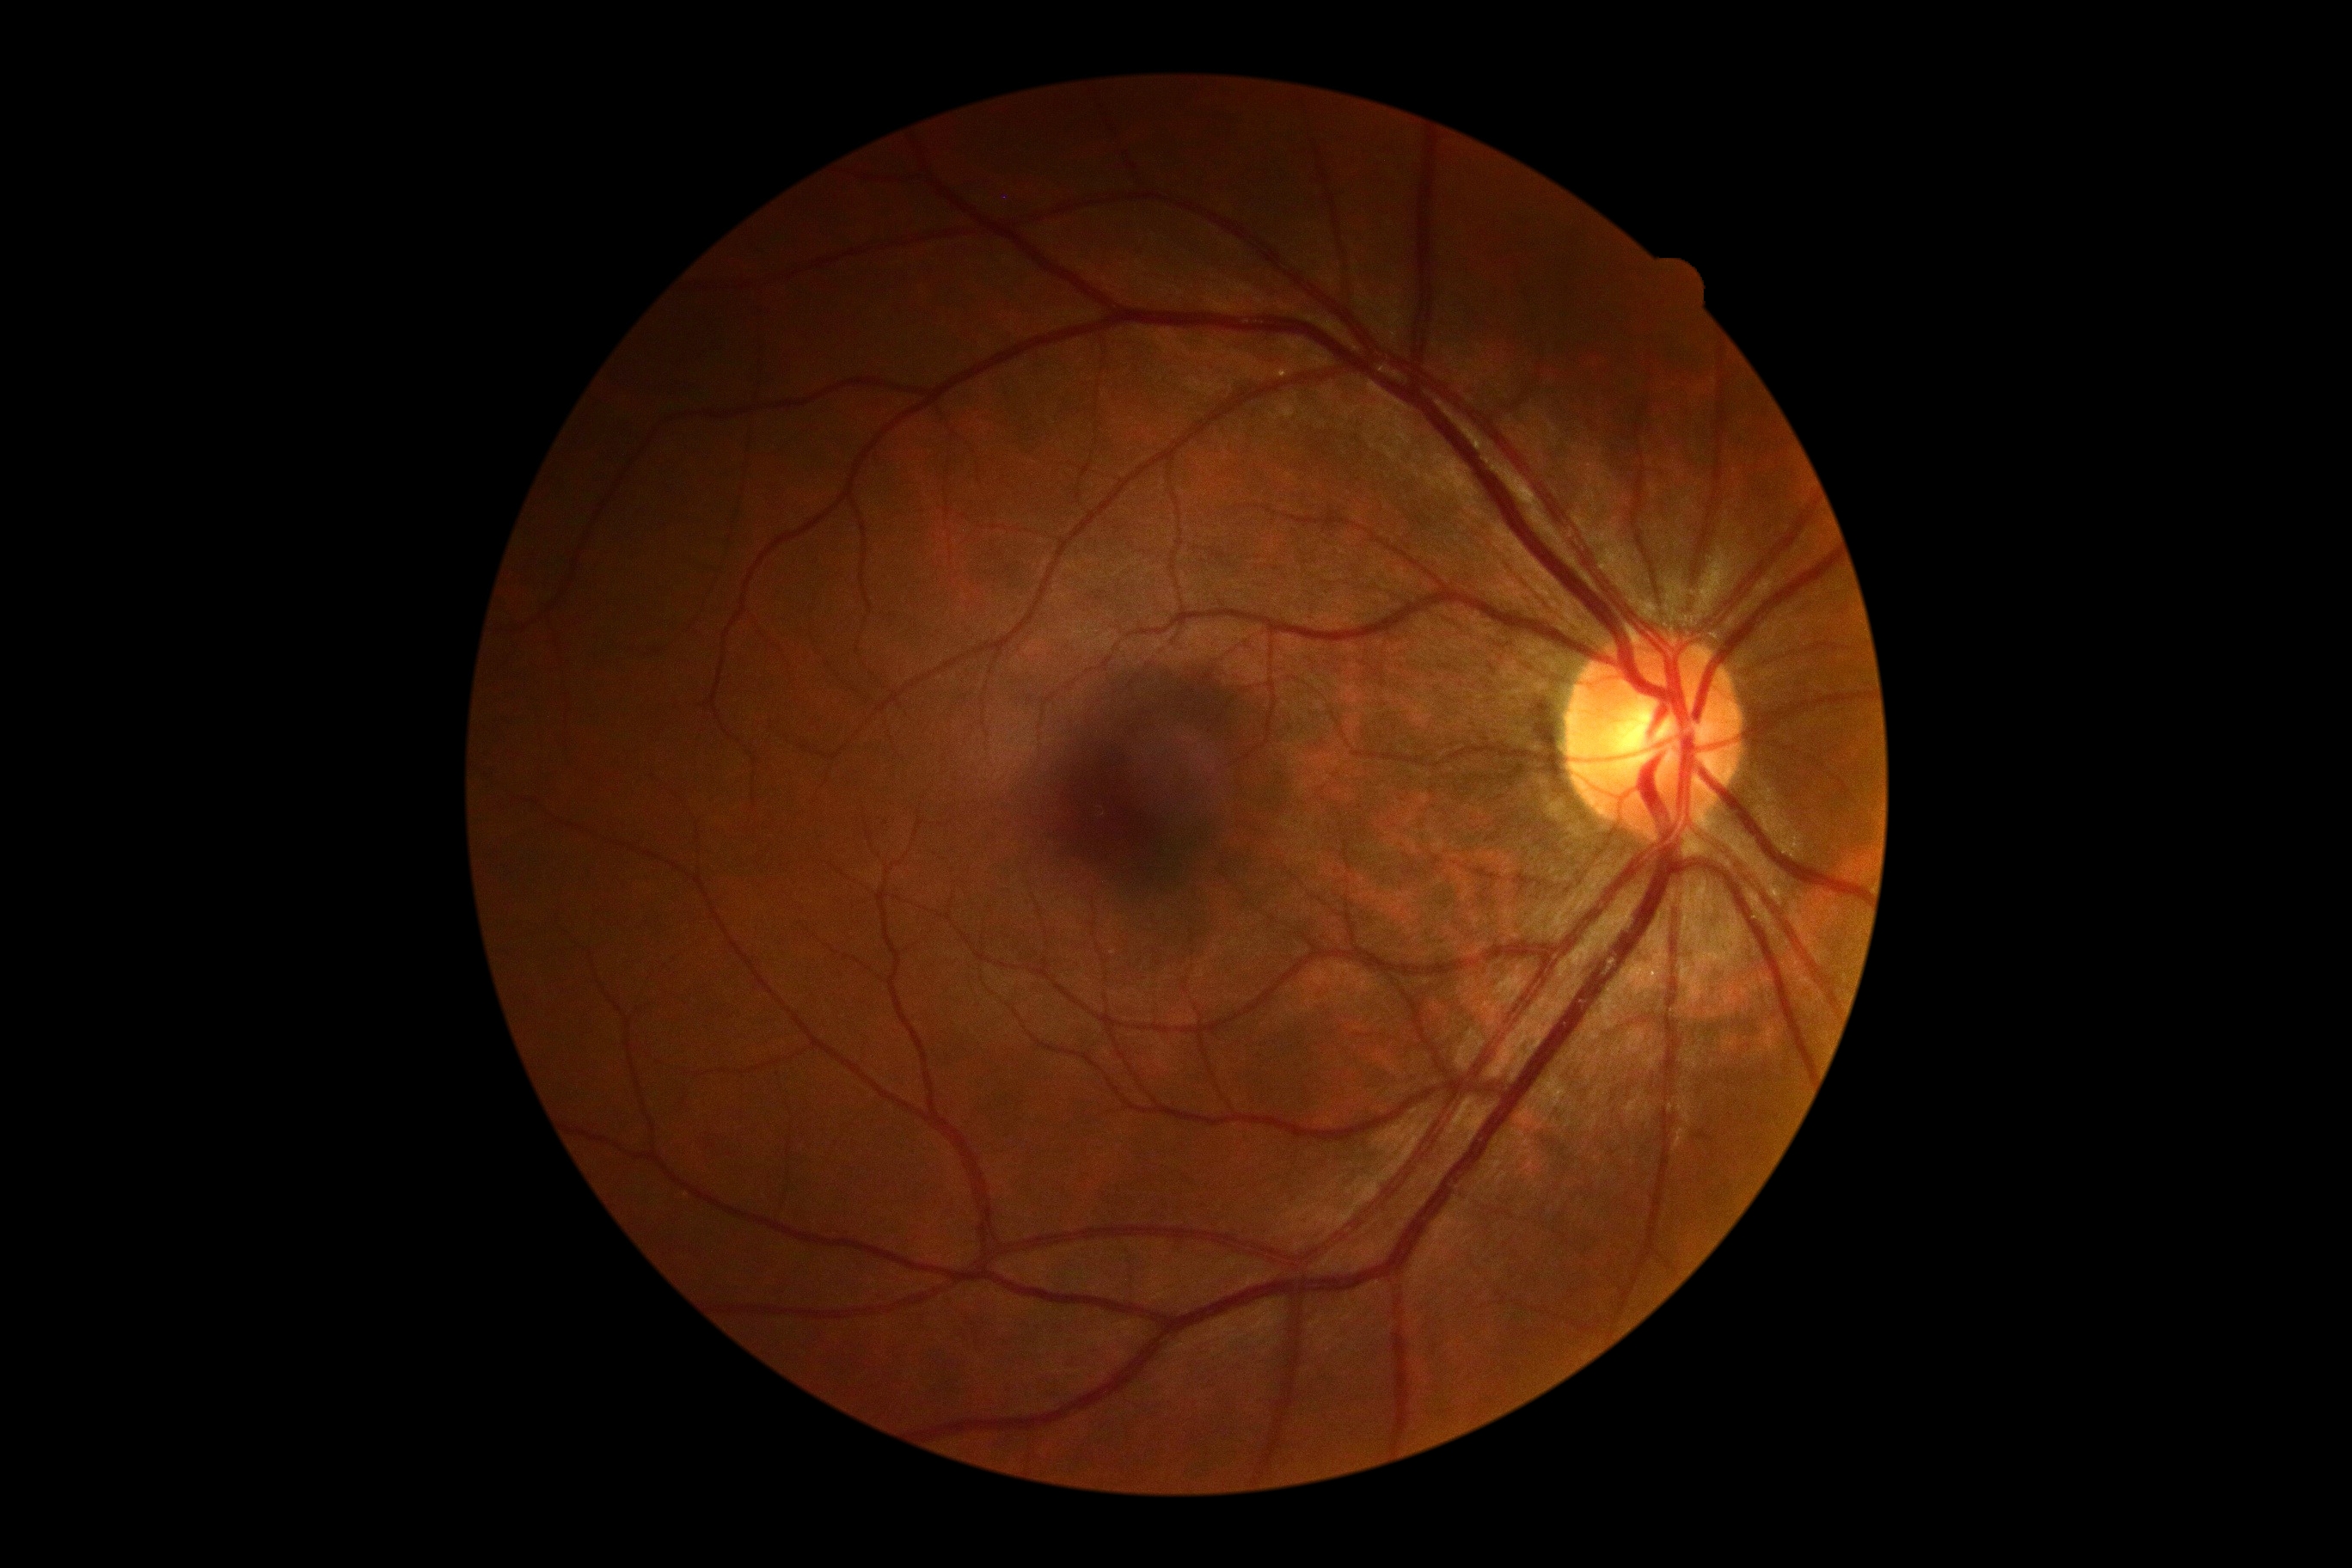

No diabetic retinal disease findings.
DR severity is grade 0 (no apparent retinopathy).